45° FOV, 2048x1536, color fundus photograph — 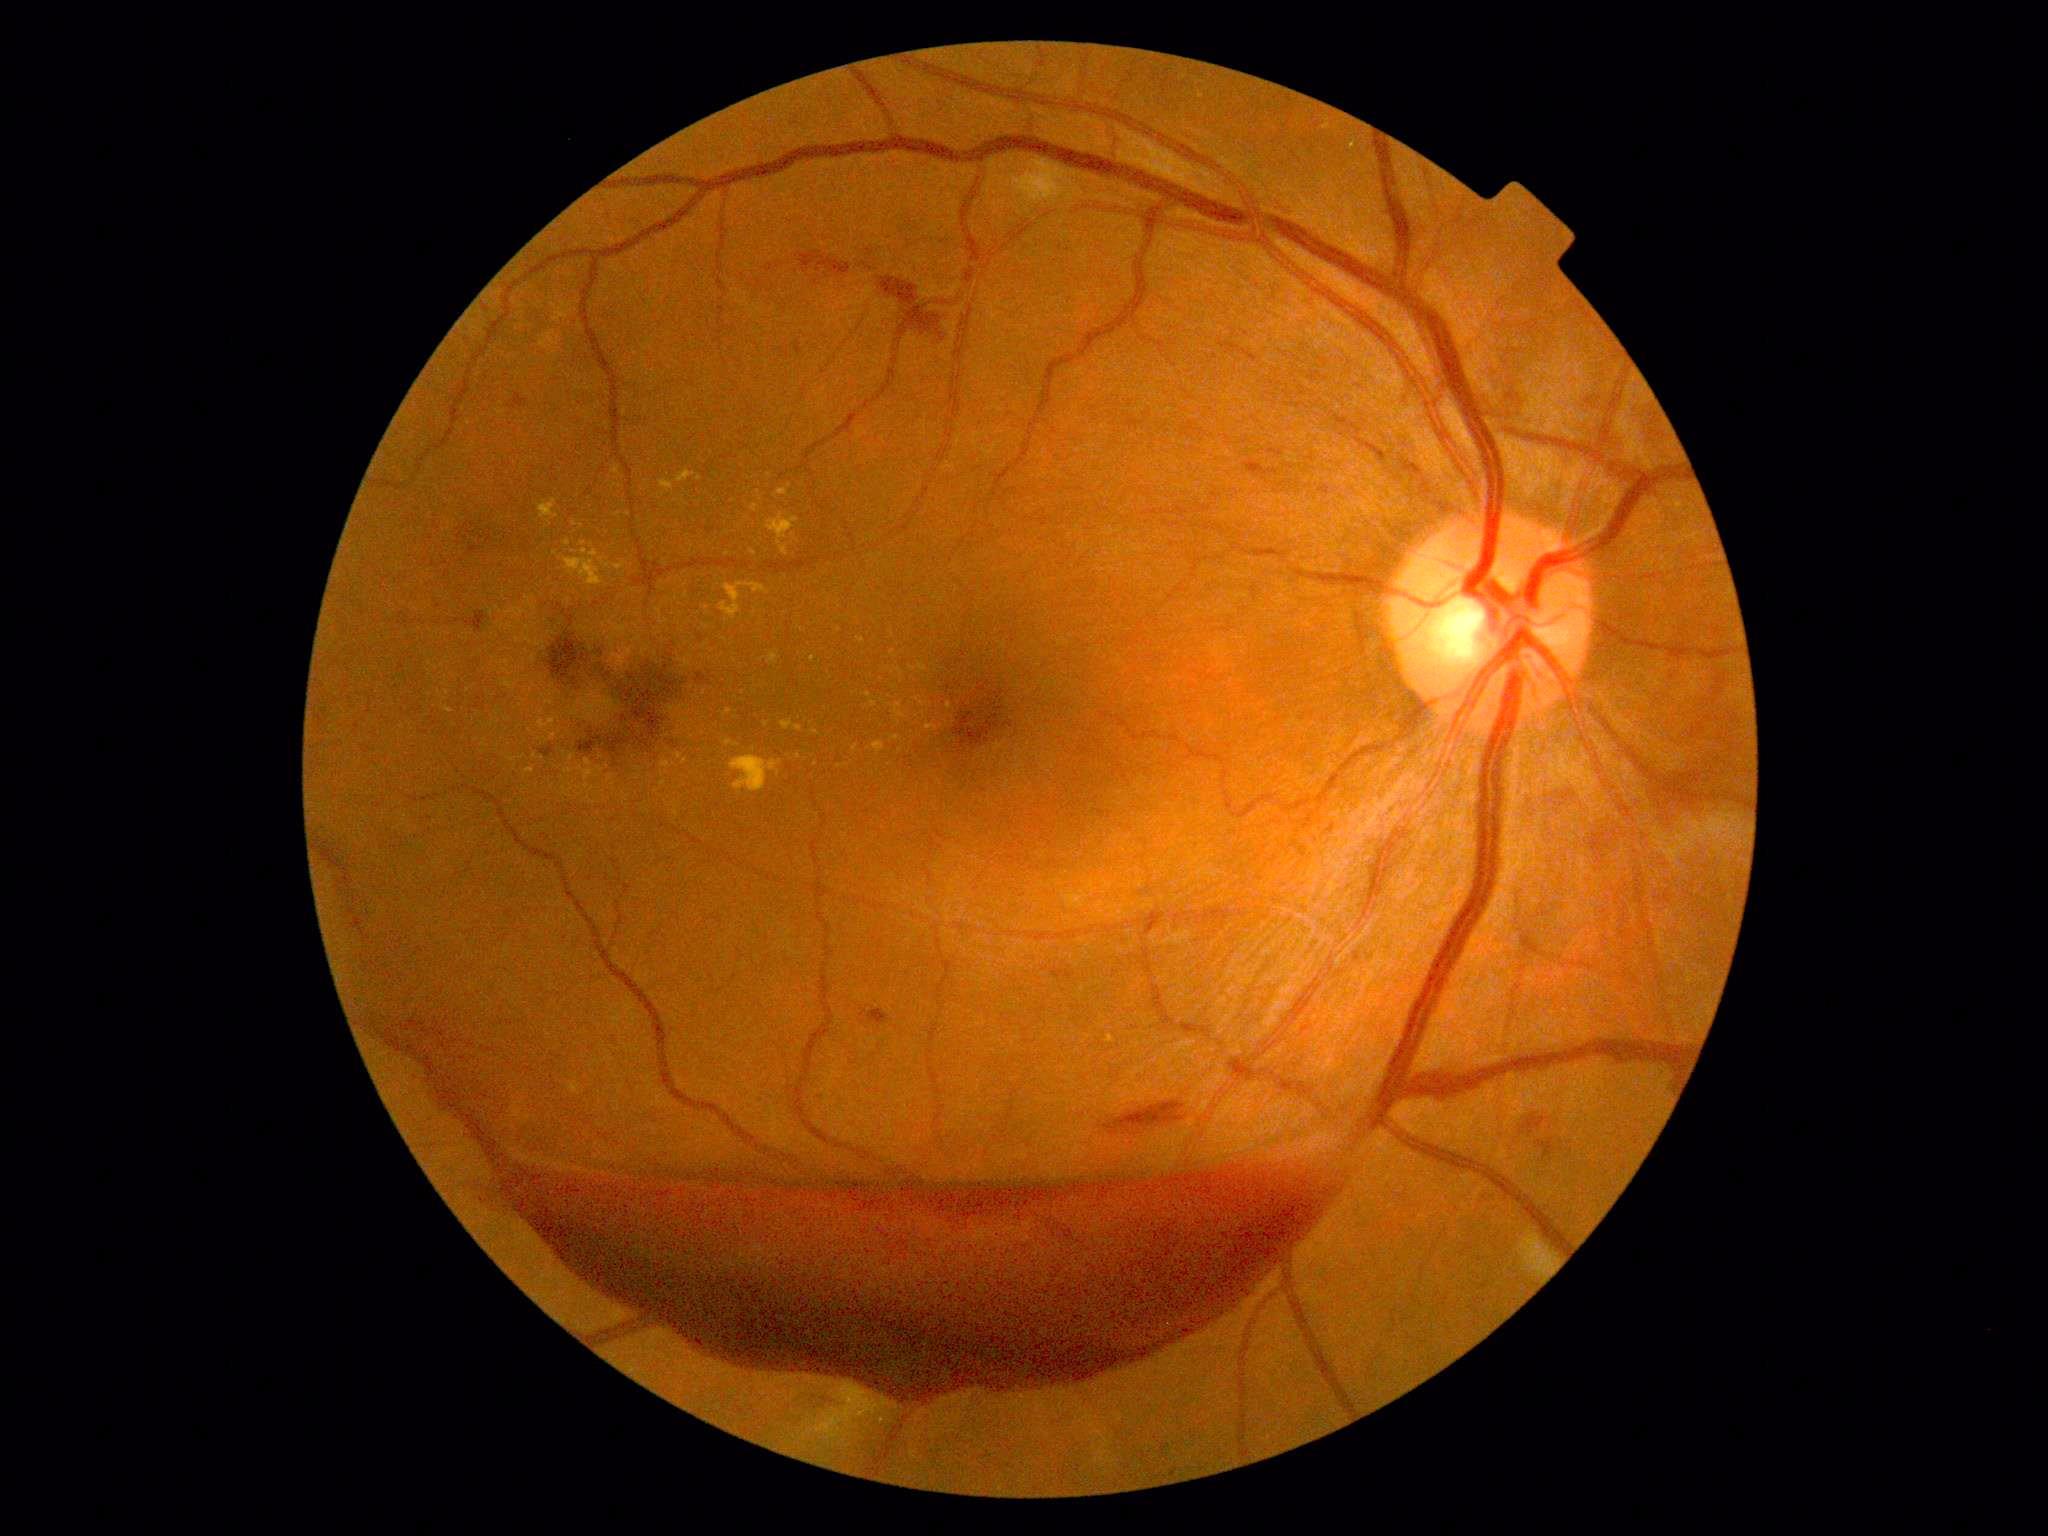

<lesions partial="true">
  <dr_grade>4</dr_grade>
  <ex partial="true">rect(660, 759, 676, 769) | rect(562, 787, 570, 798) | rect(522, 626, 546, 647) | rect(501, 680, 518, 691) | rect(720, 583, 771, 620) | rect(612, 466, 620, 475) | rect(612, 483, 622, 489)</ex>
  <ex_small>(523,756) | (583,544) | (799,757) | (855,748) | (755,613) | (725,640) | (572,758) | (575,525) | (793,535) | (447,693) | (677,598)</ex_small>
  <he partial="true">rect(368, 1020, 1359, 1404) | rect(509, 394, 529, 409) | rect(881, 277, 946, 342) | rect(539, 745, 555, 758) | rect(765, 264, 774, 273) | rect(777, 261, 782, 269) | rect(868, 1010, 889, 1027) | rect(797, 252, 851, 276) | rect(1520, 1115, 1548, 1136) | rect(1244, 461, 1279, 481) | rect(1105, 1102, 1185, 1135) | rect(793, 341, 802, 355) | rect(1336, 415, 1363, 435) | rect(1355, 438, 1390, 464) | rect(1665, 1067, 1683, 1091)</he>
  <ma />
  <se>rect(1520, 1230, 1559, 1279) | rect(1023, 162, 1054, 202)</se>
</lesions>